DR severity per modified Davis staging: 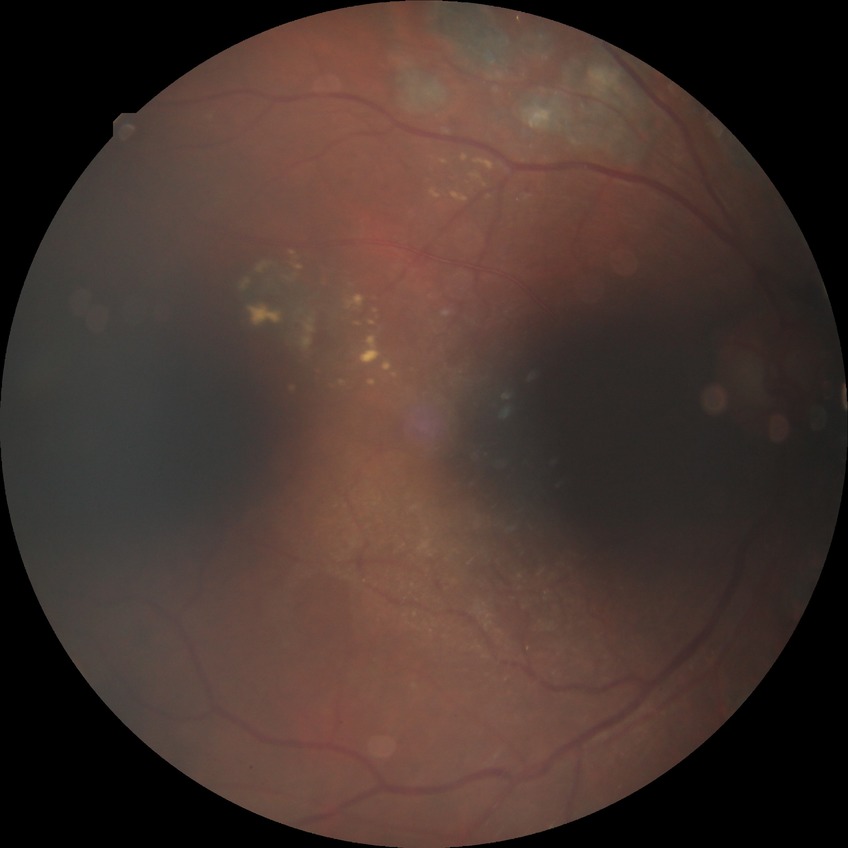
Assessment:
* diabetic retinopathy (DR): PDR (proliferative diabetic retinopathy)